Wide-field fundus photograph of an infant.
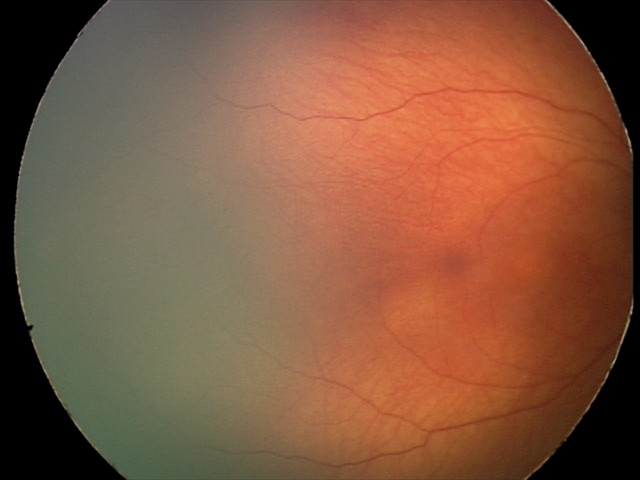 Screening examination with no abnormal retinal findings.